100° field of view (Phoenix ICON). Infant wide-field fundus photograph
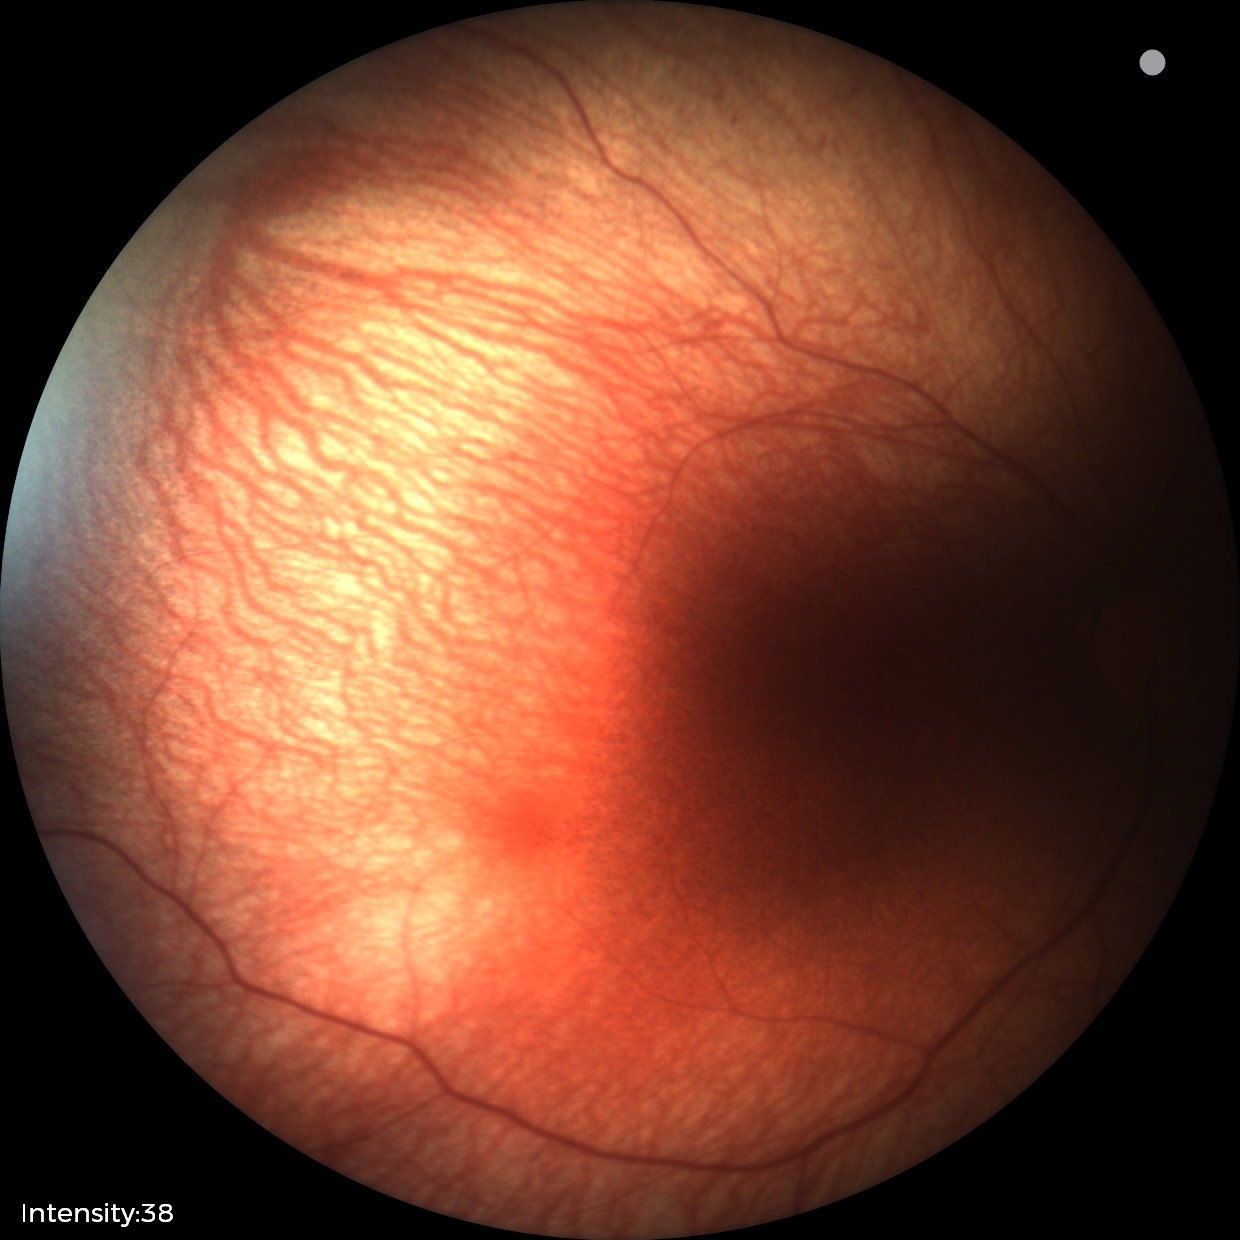

Impression: physiological finding.